Image size 2228x1652 — 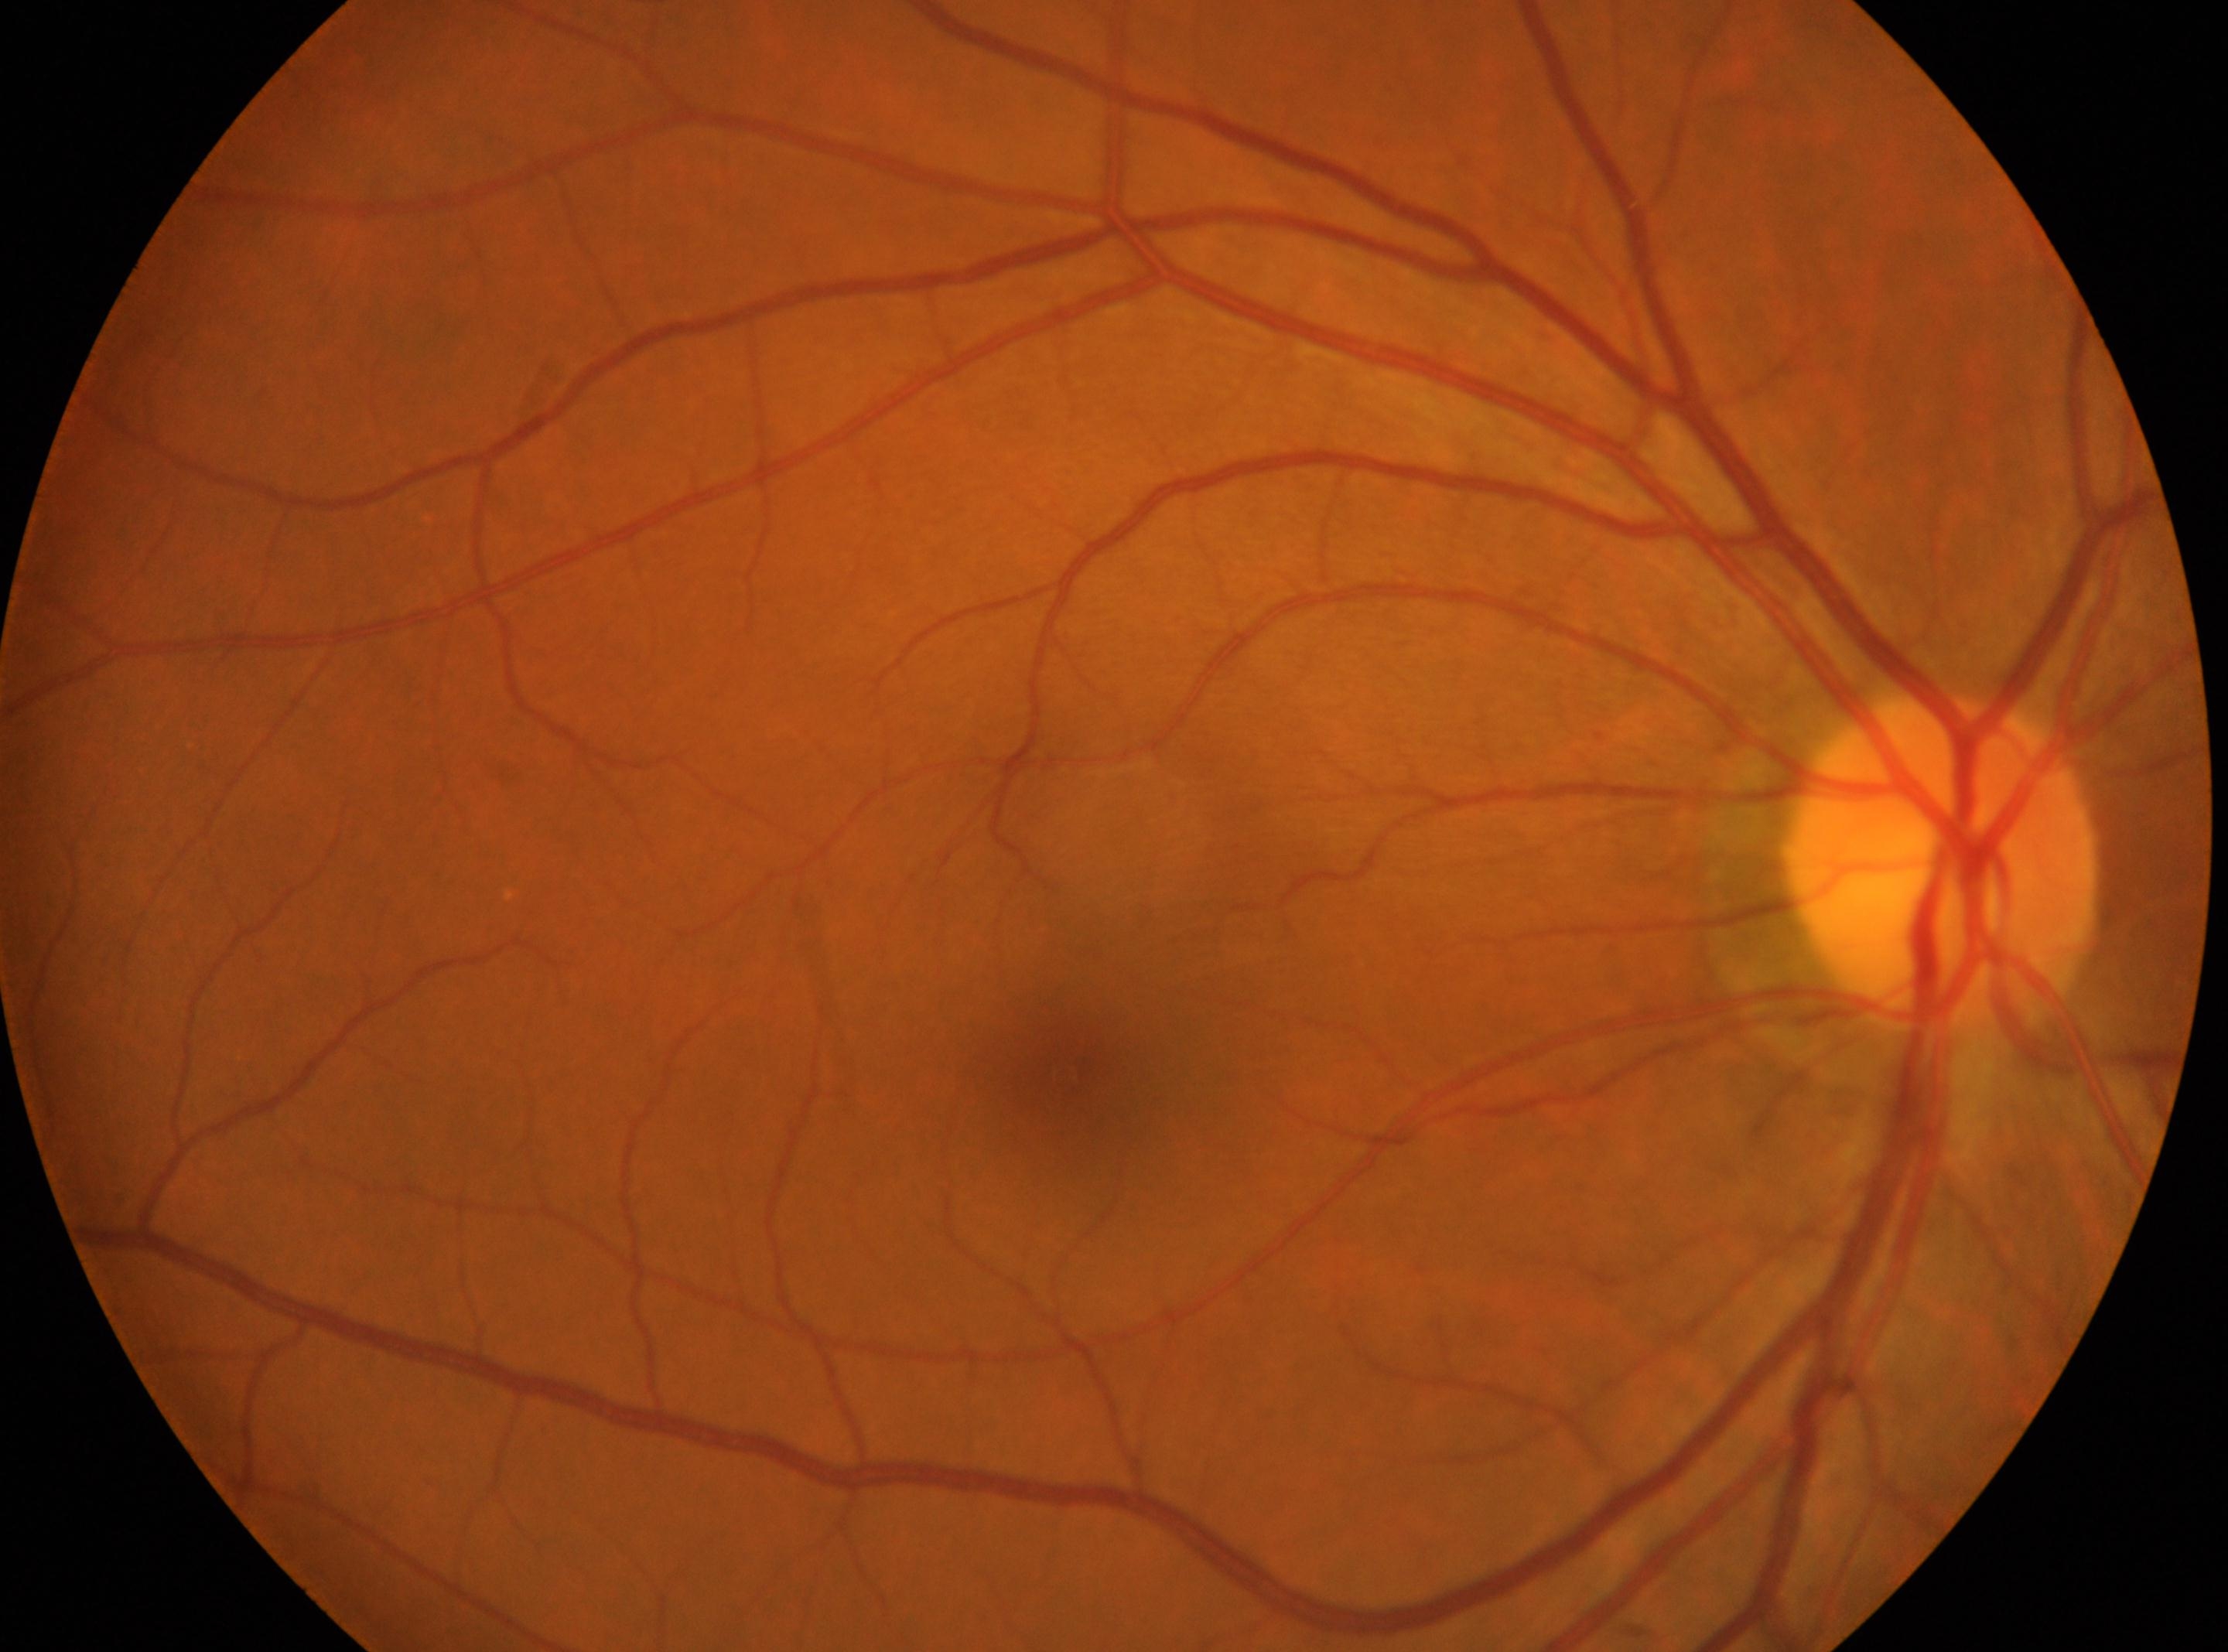 Diabetic retinopathy: grade 0 (no apparent retinopathy). This is the right eye. Optic disc located at (x=1941, y=865). Fovea center: (x=1063, y=1077).